45-degree field of view · 2352 by 1568 pixels · CFP: 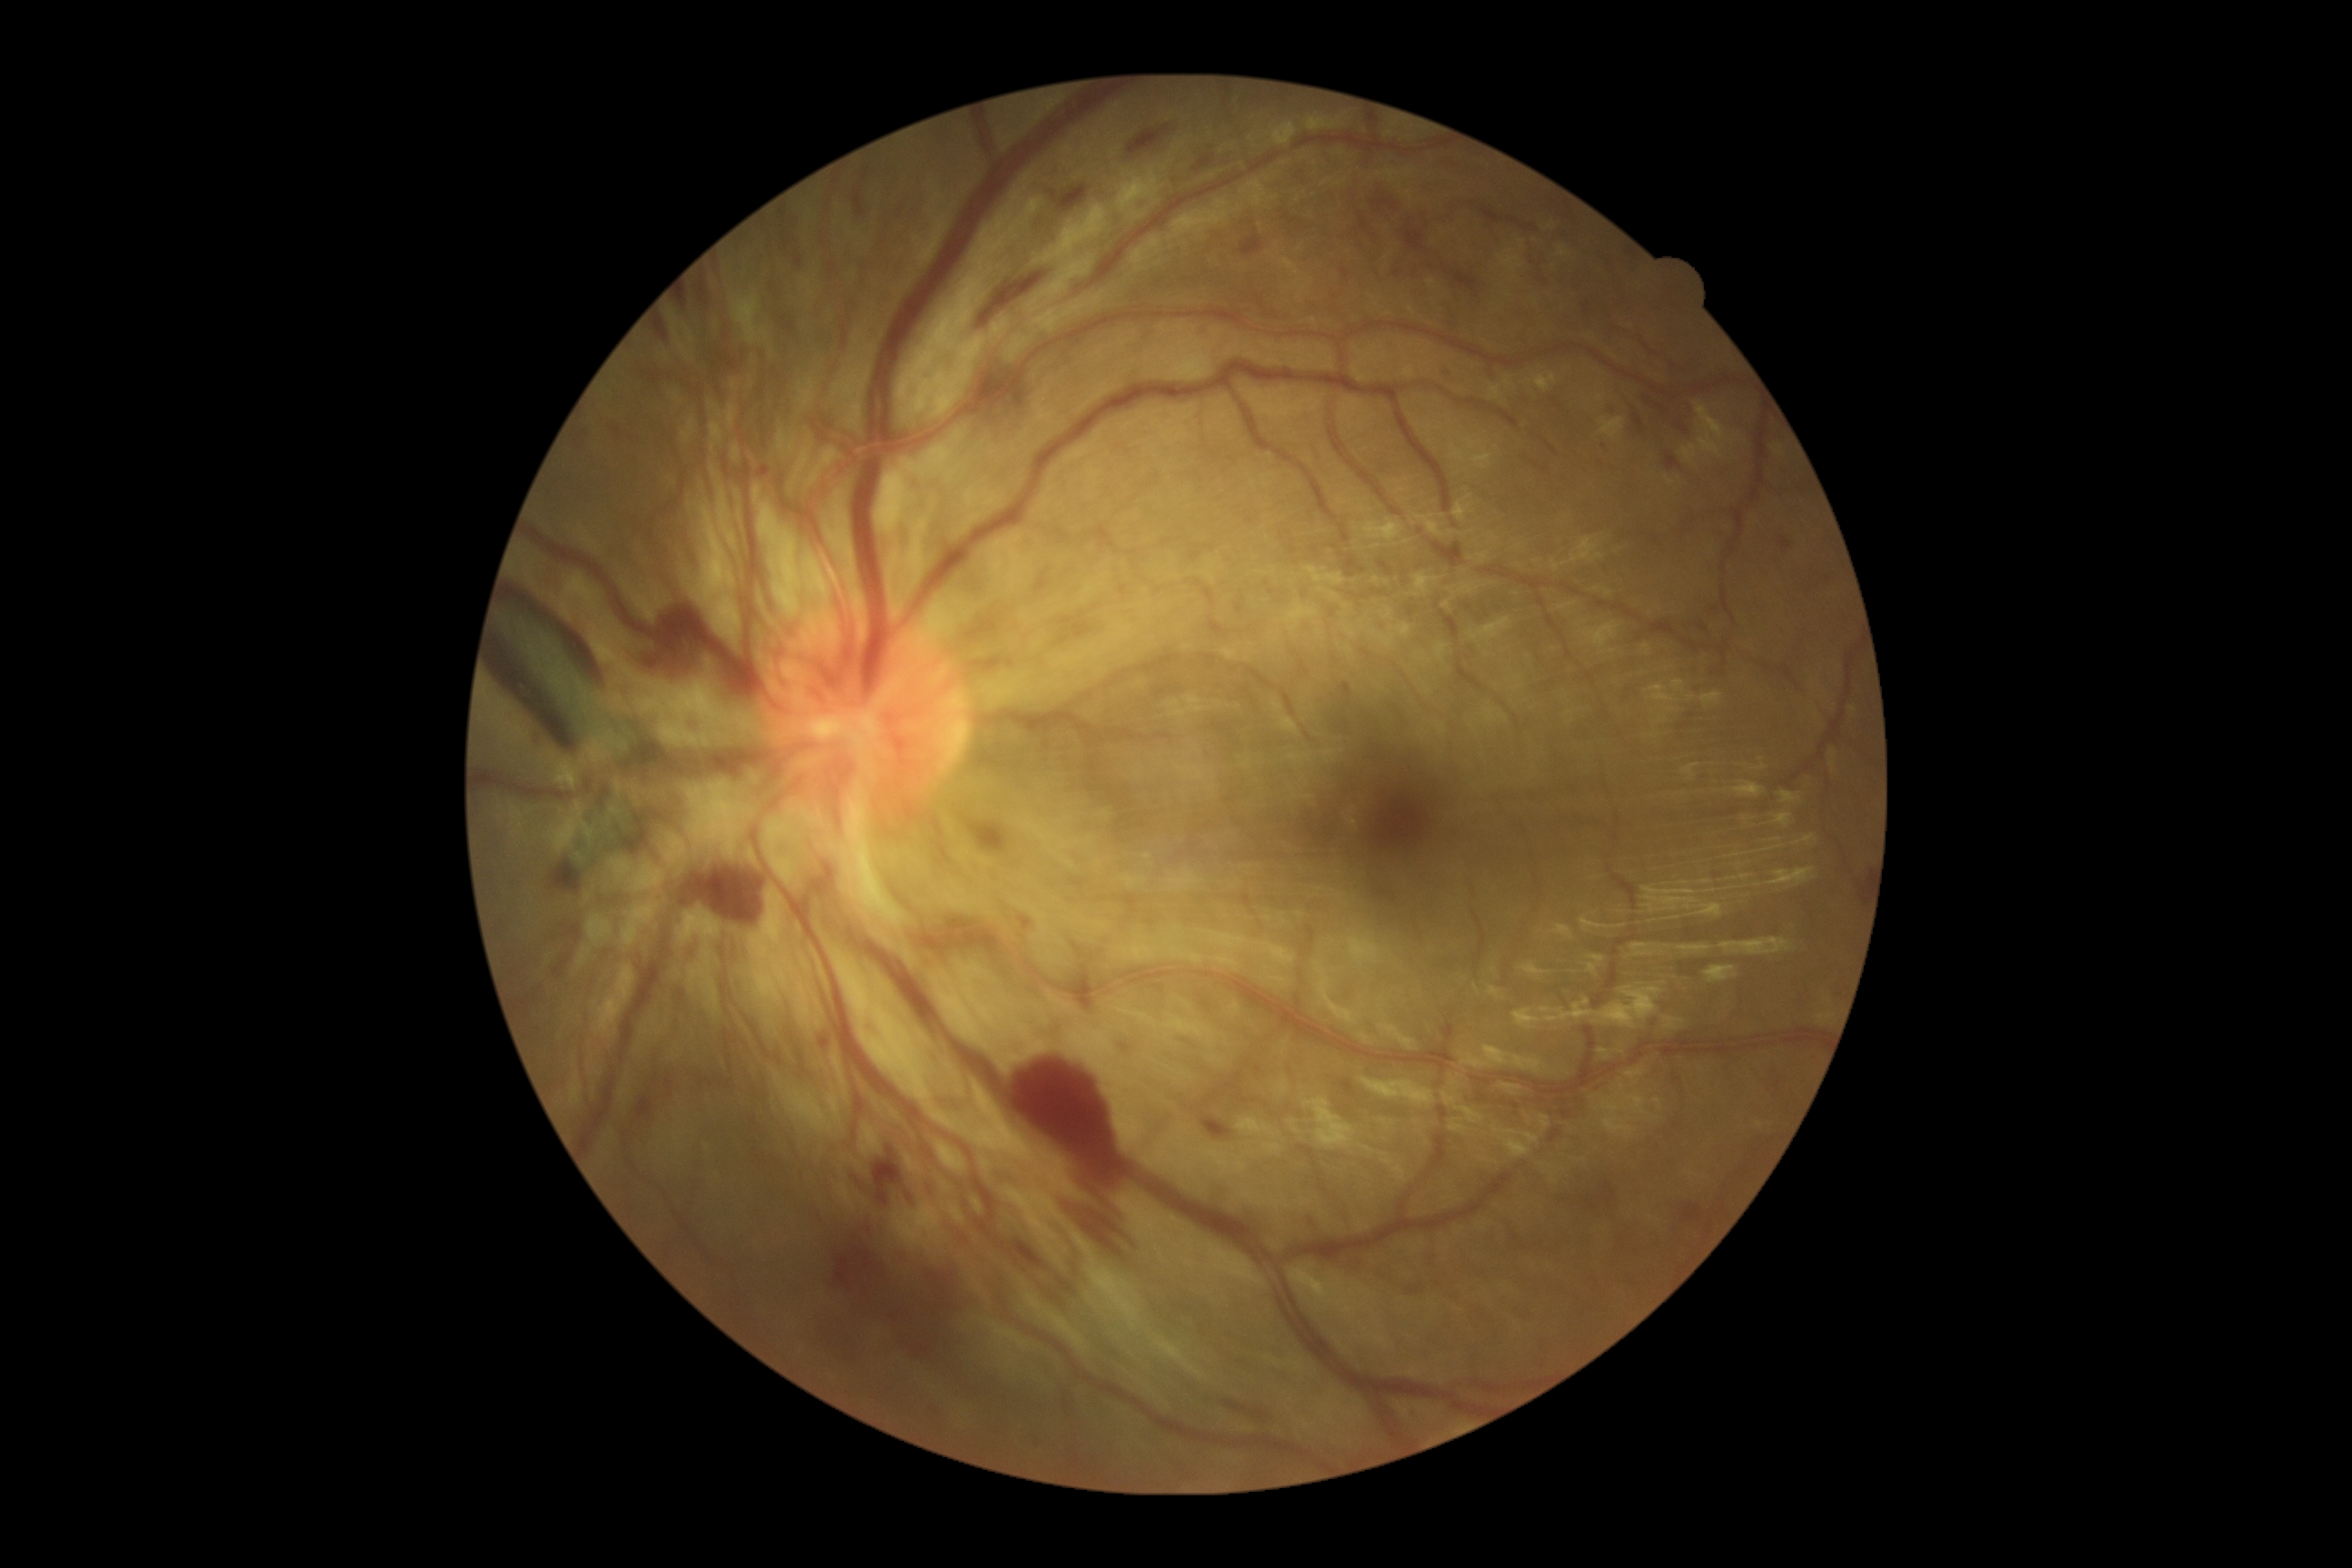 Diabetic retinopathy severity: grade 4 (PDR) — neovascularization and/or vitreous/pre-retinal hemorrhage.